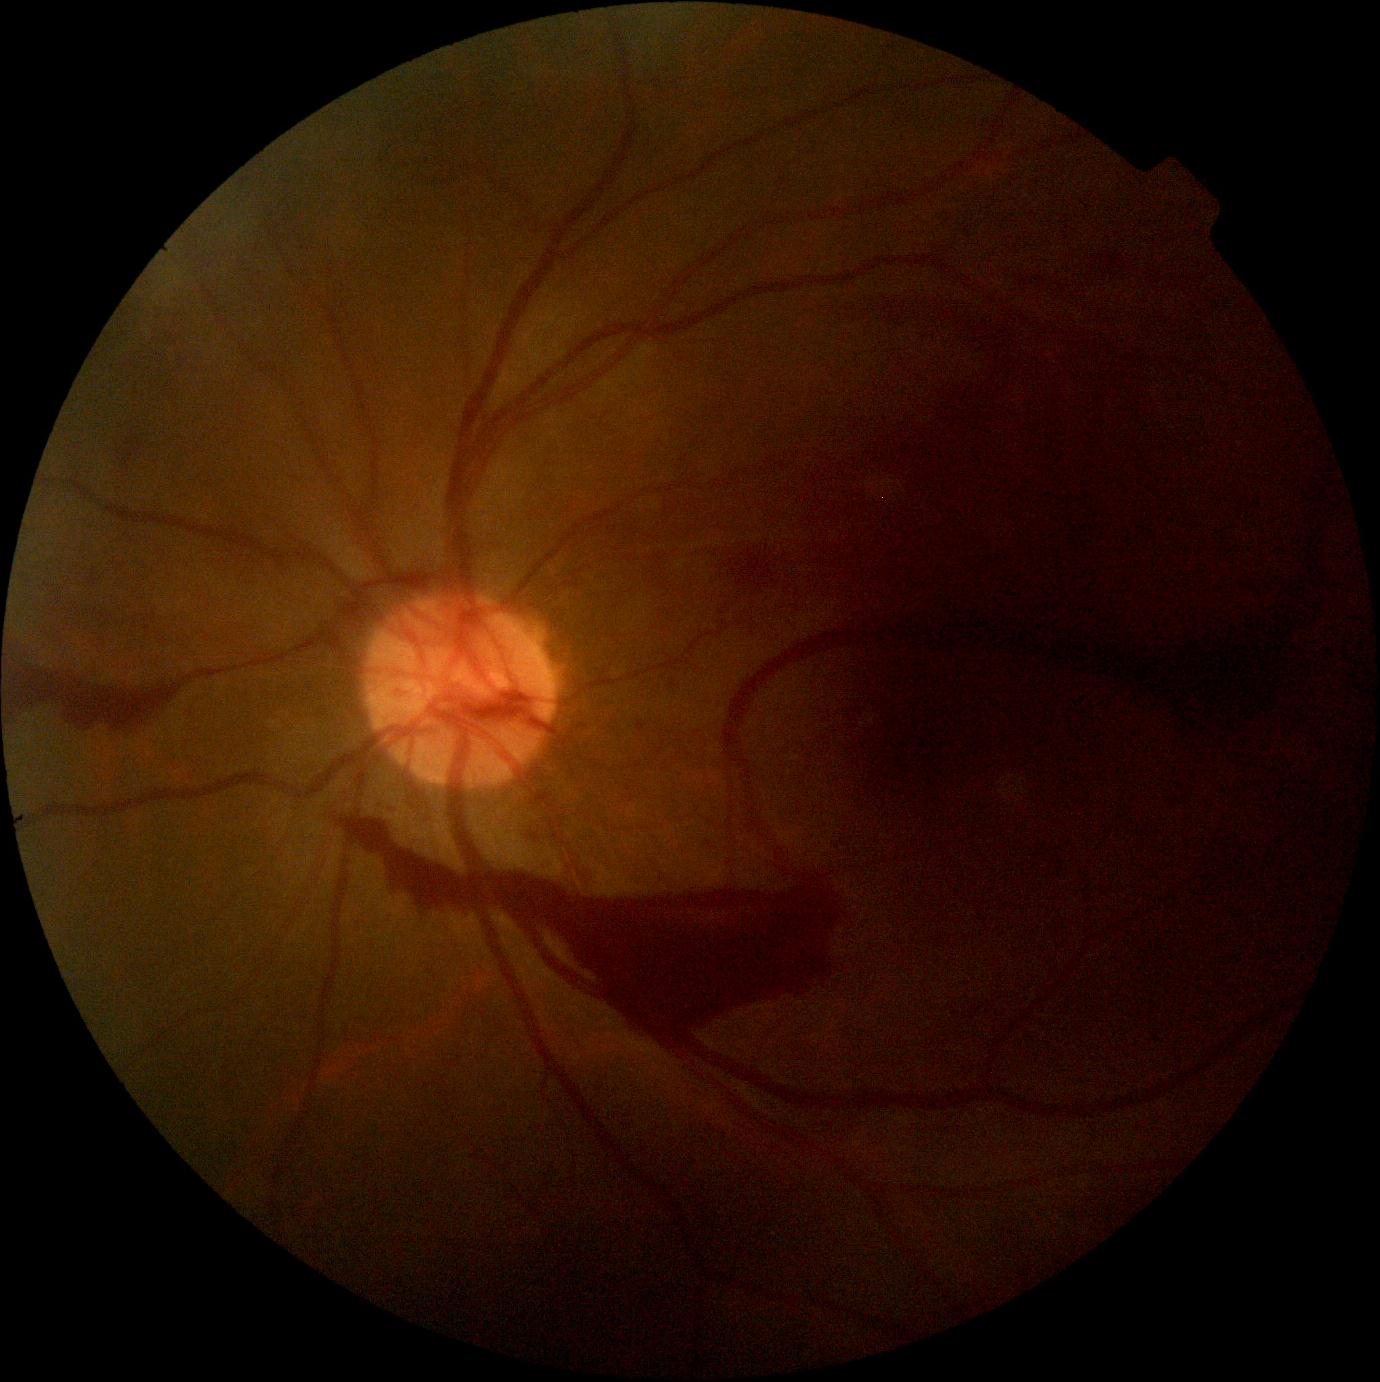 DR severity is 4.
DR class: proliferative diabetic retinopathy.